Wide-field fundus photograph of an infant; 640x480px:
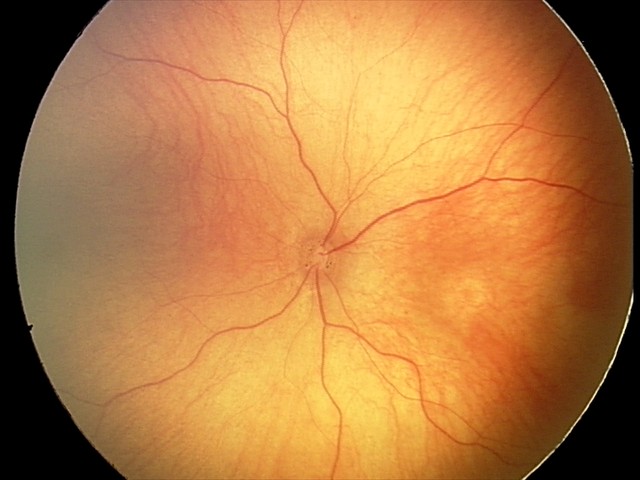

Assessment: physiological finding.